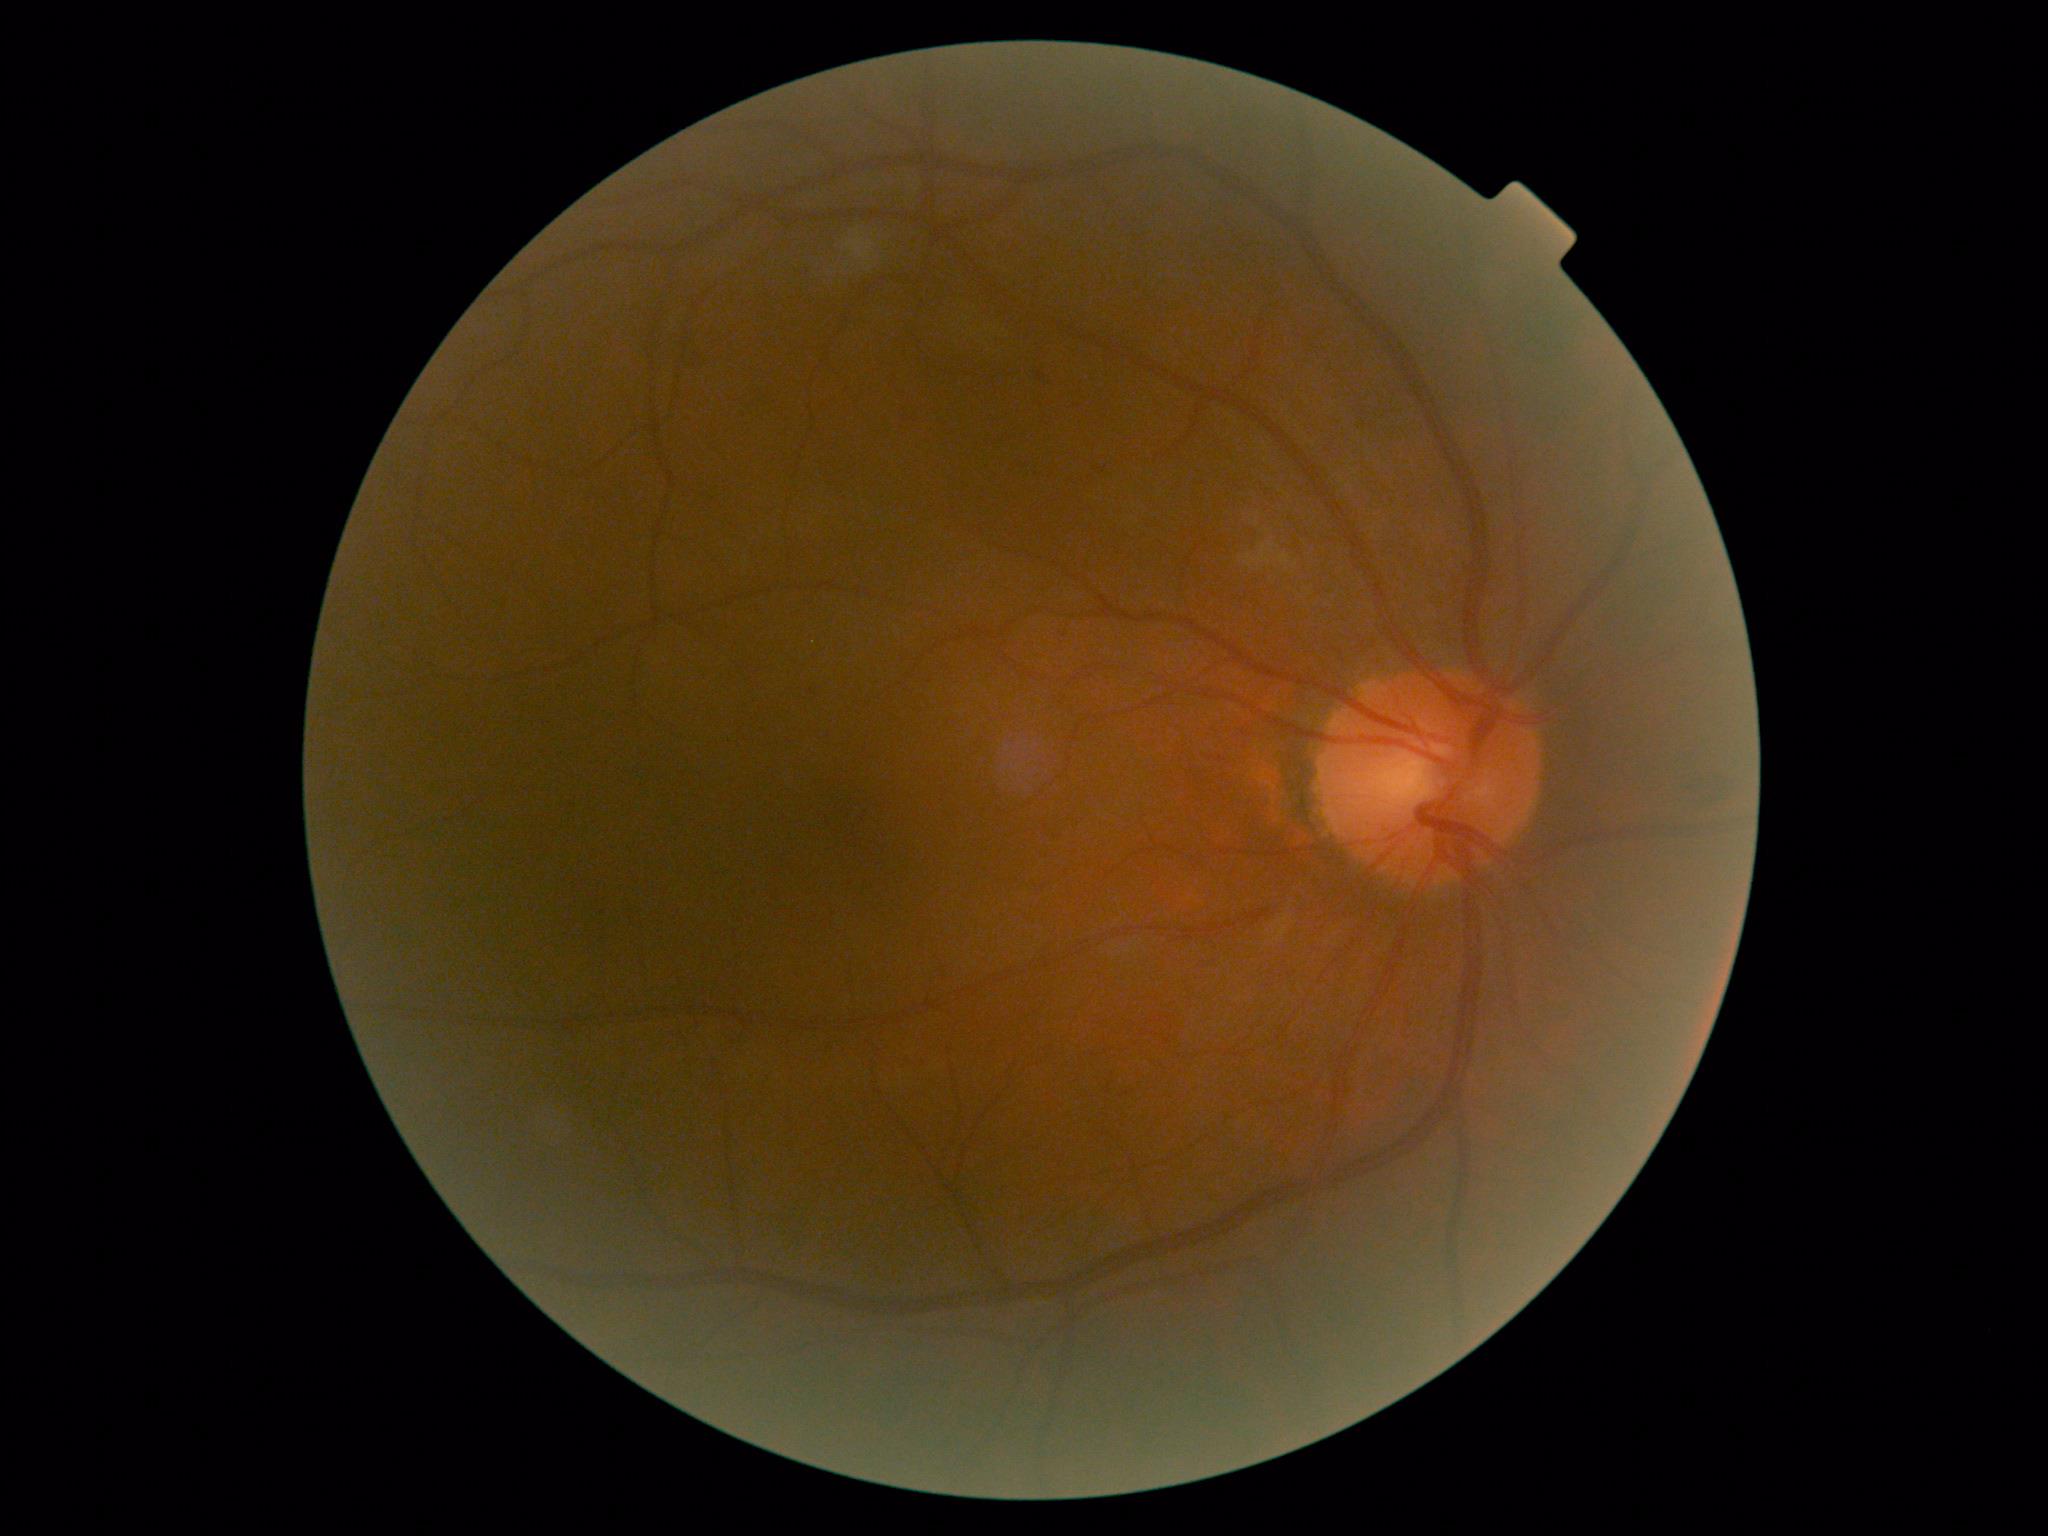

diabetic retinopathy severity=2/4; DR class=non-proliferative diabetic retinopathy.